2352 x 1568 pixels:
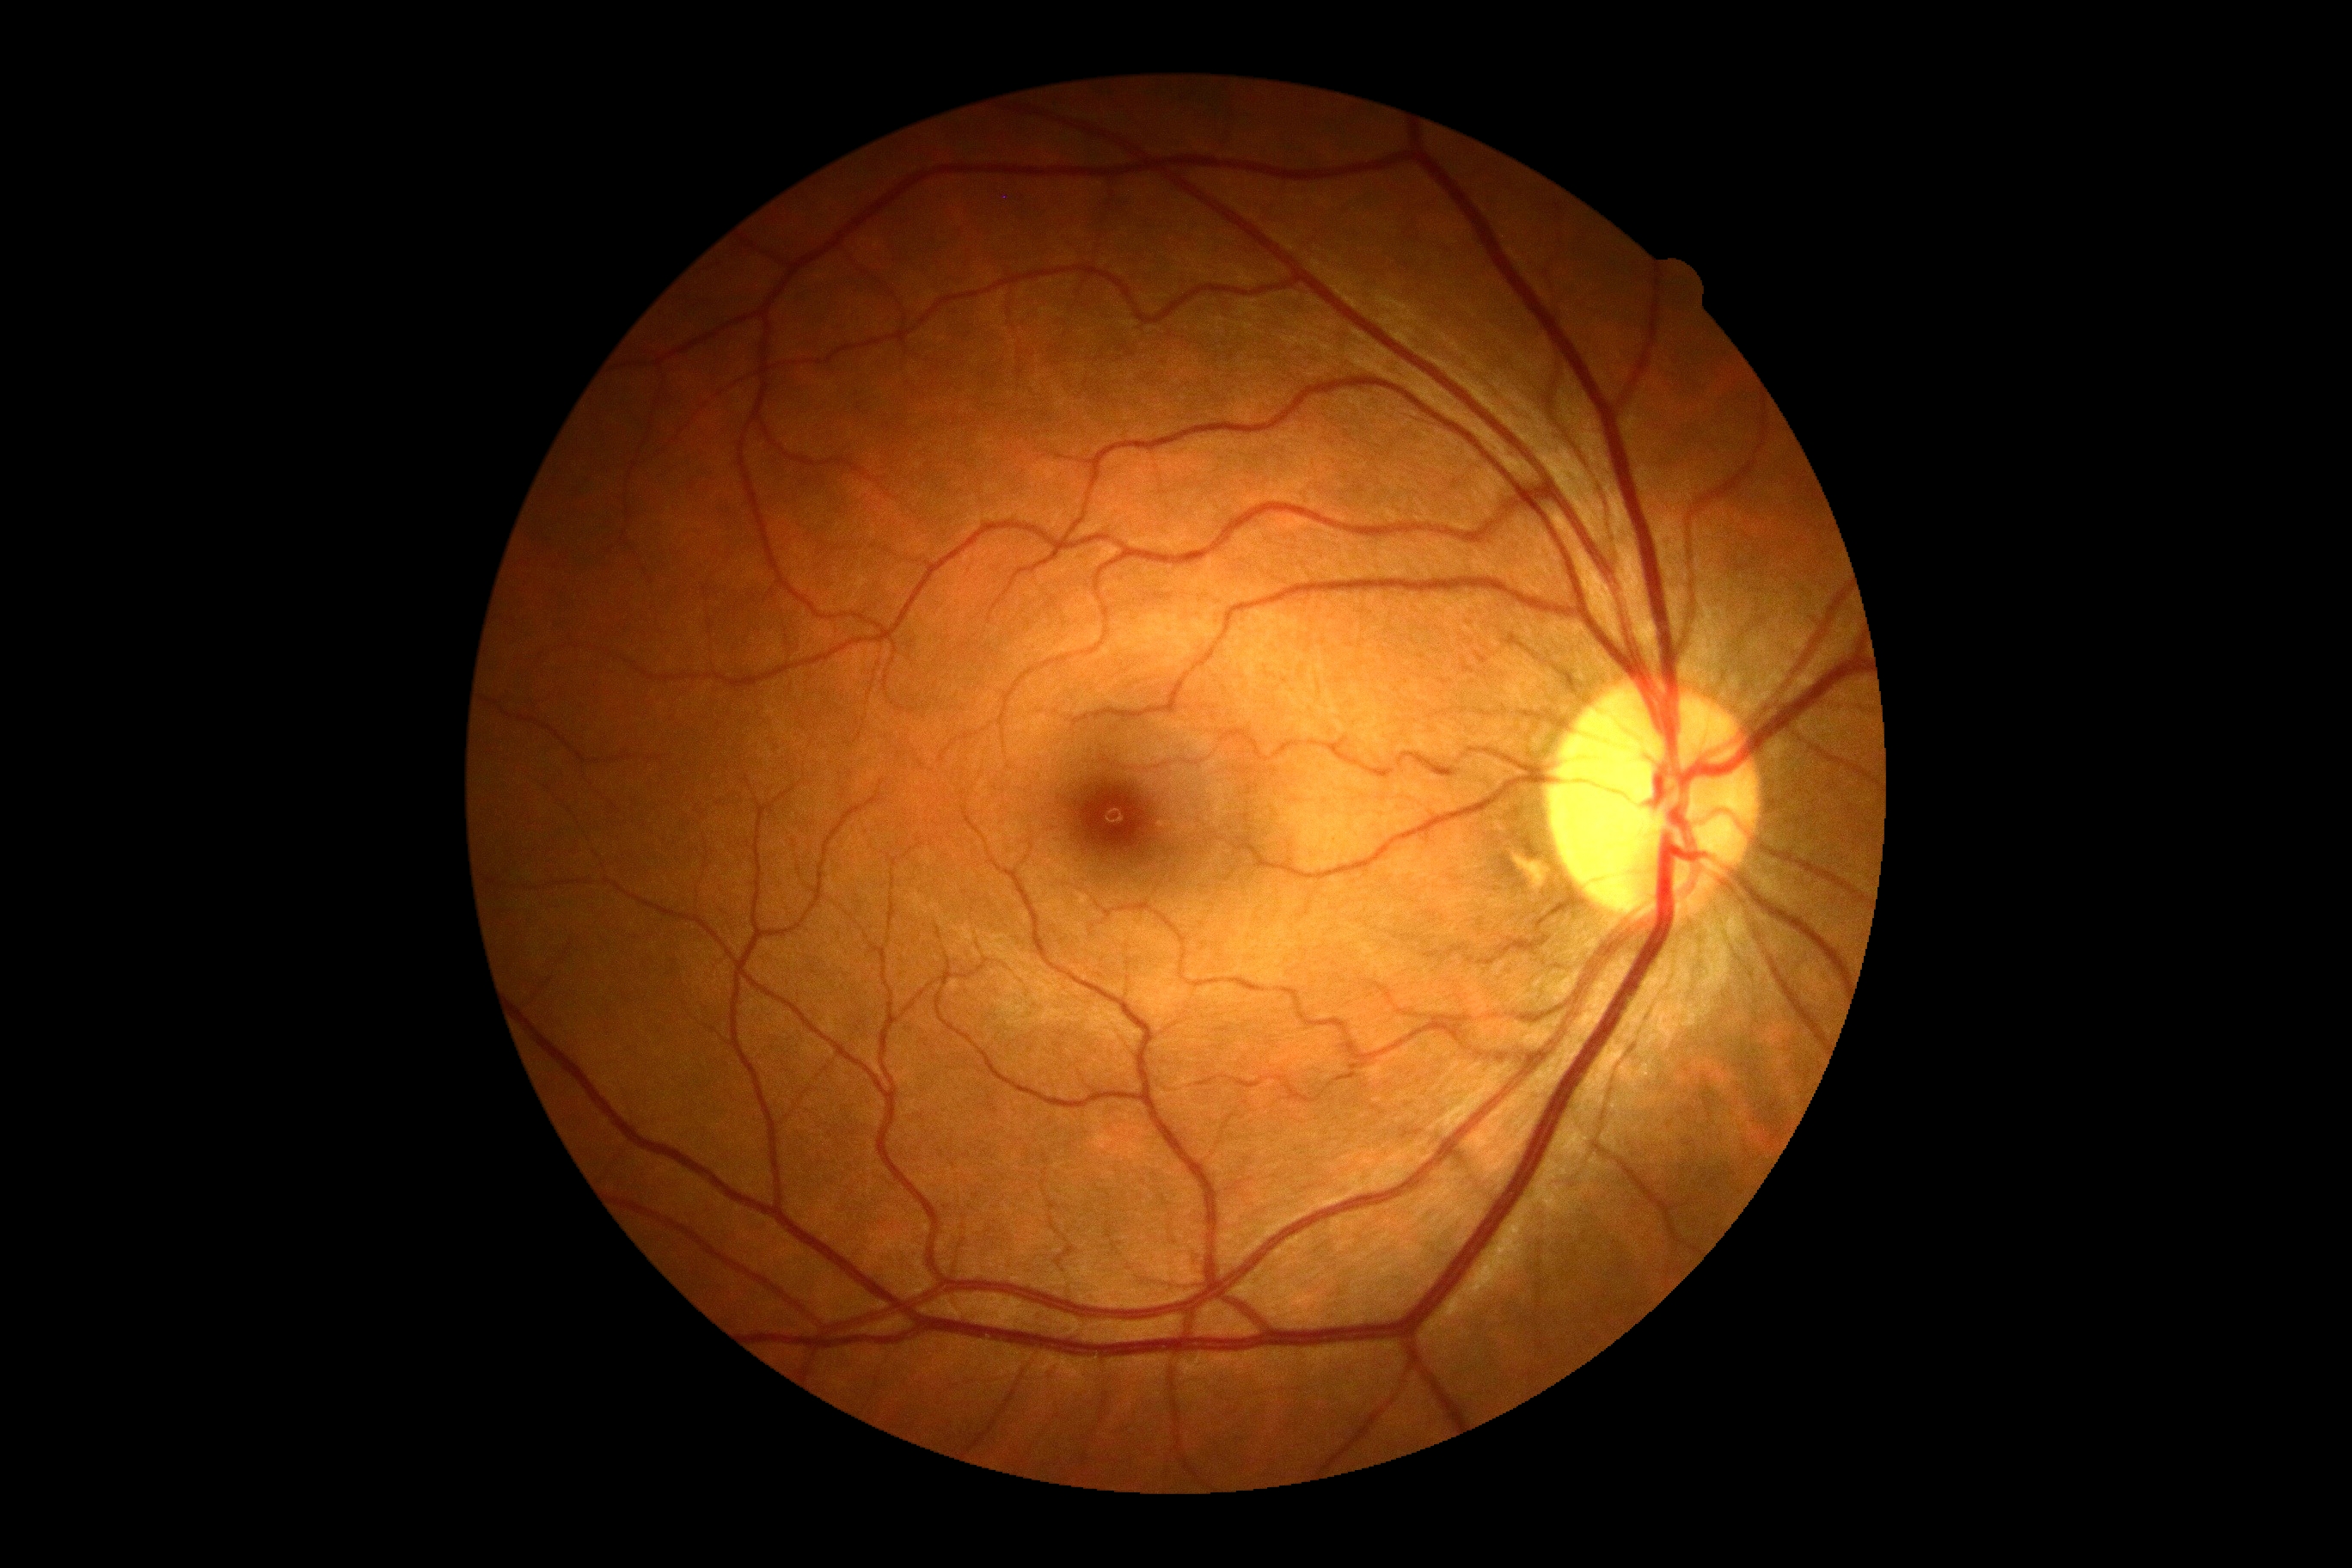 • diabetic retinopathy — 0/4